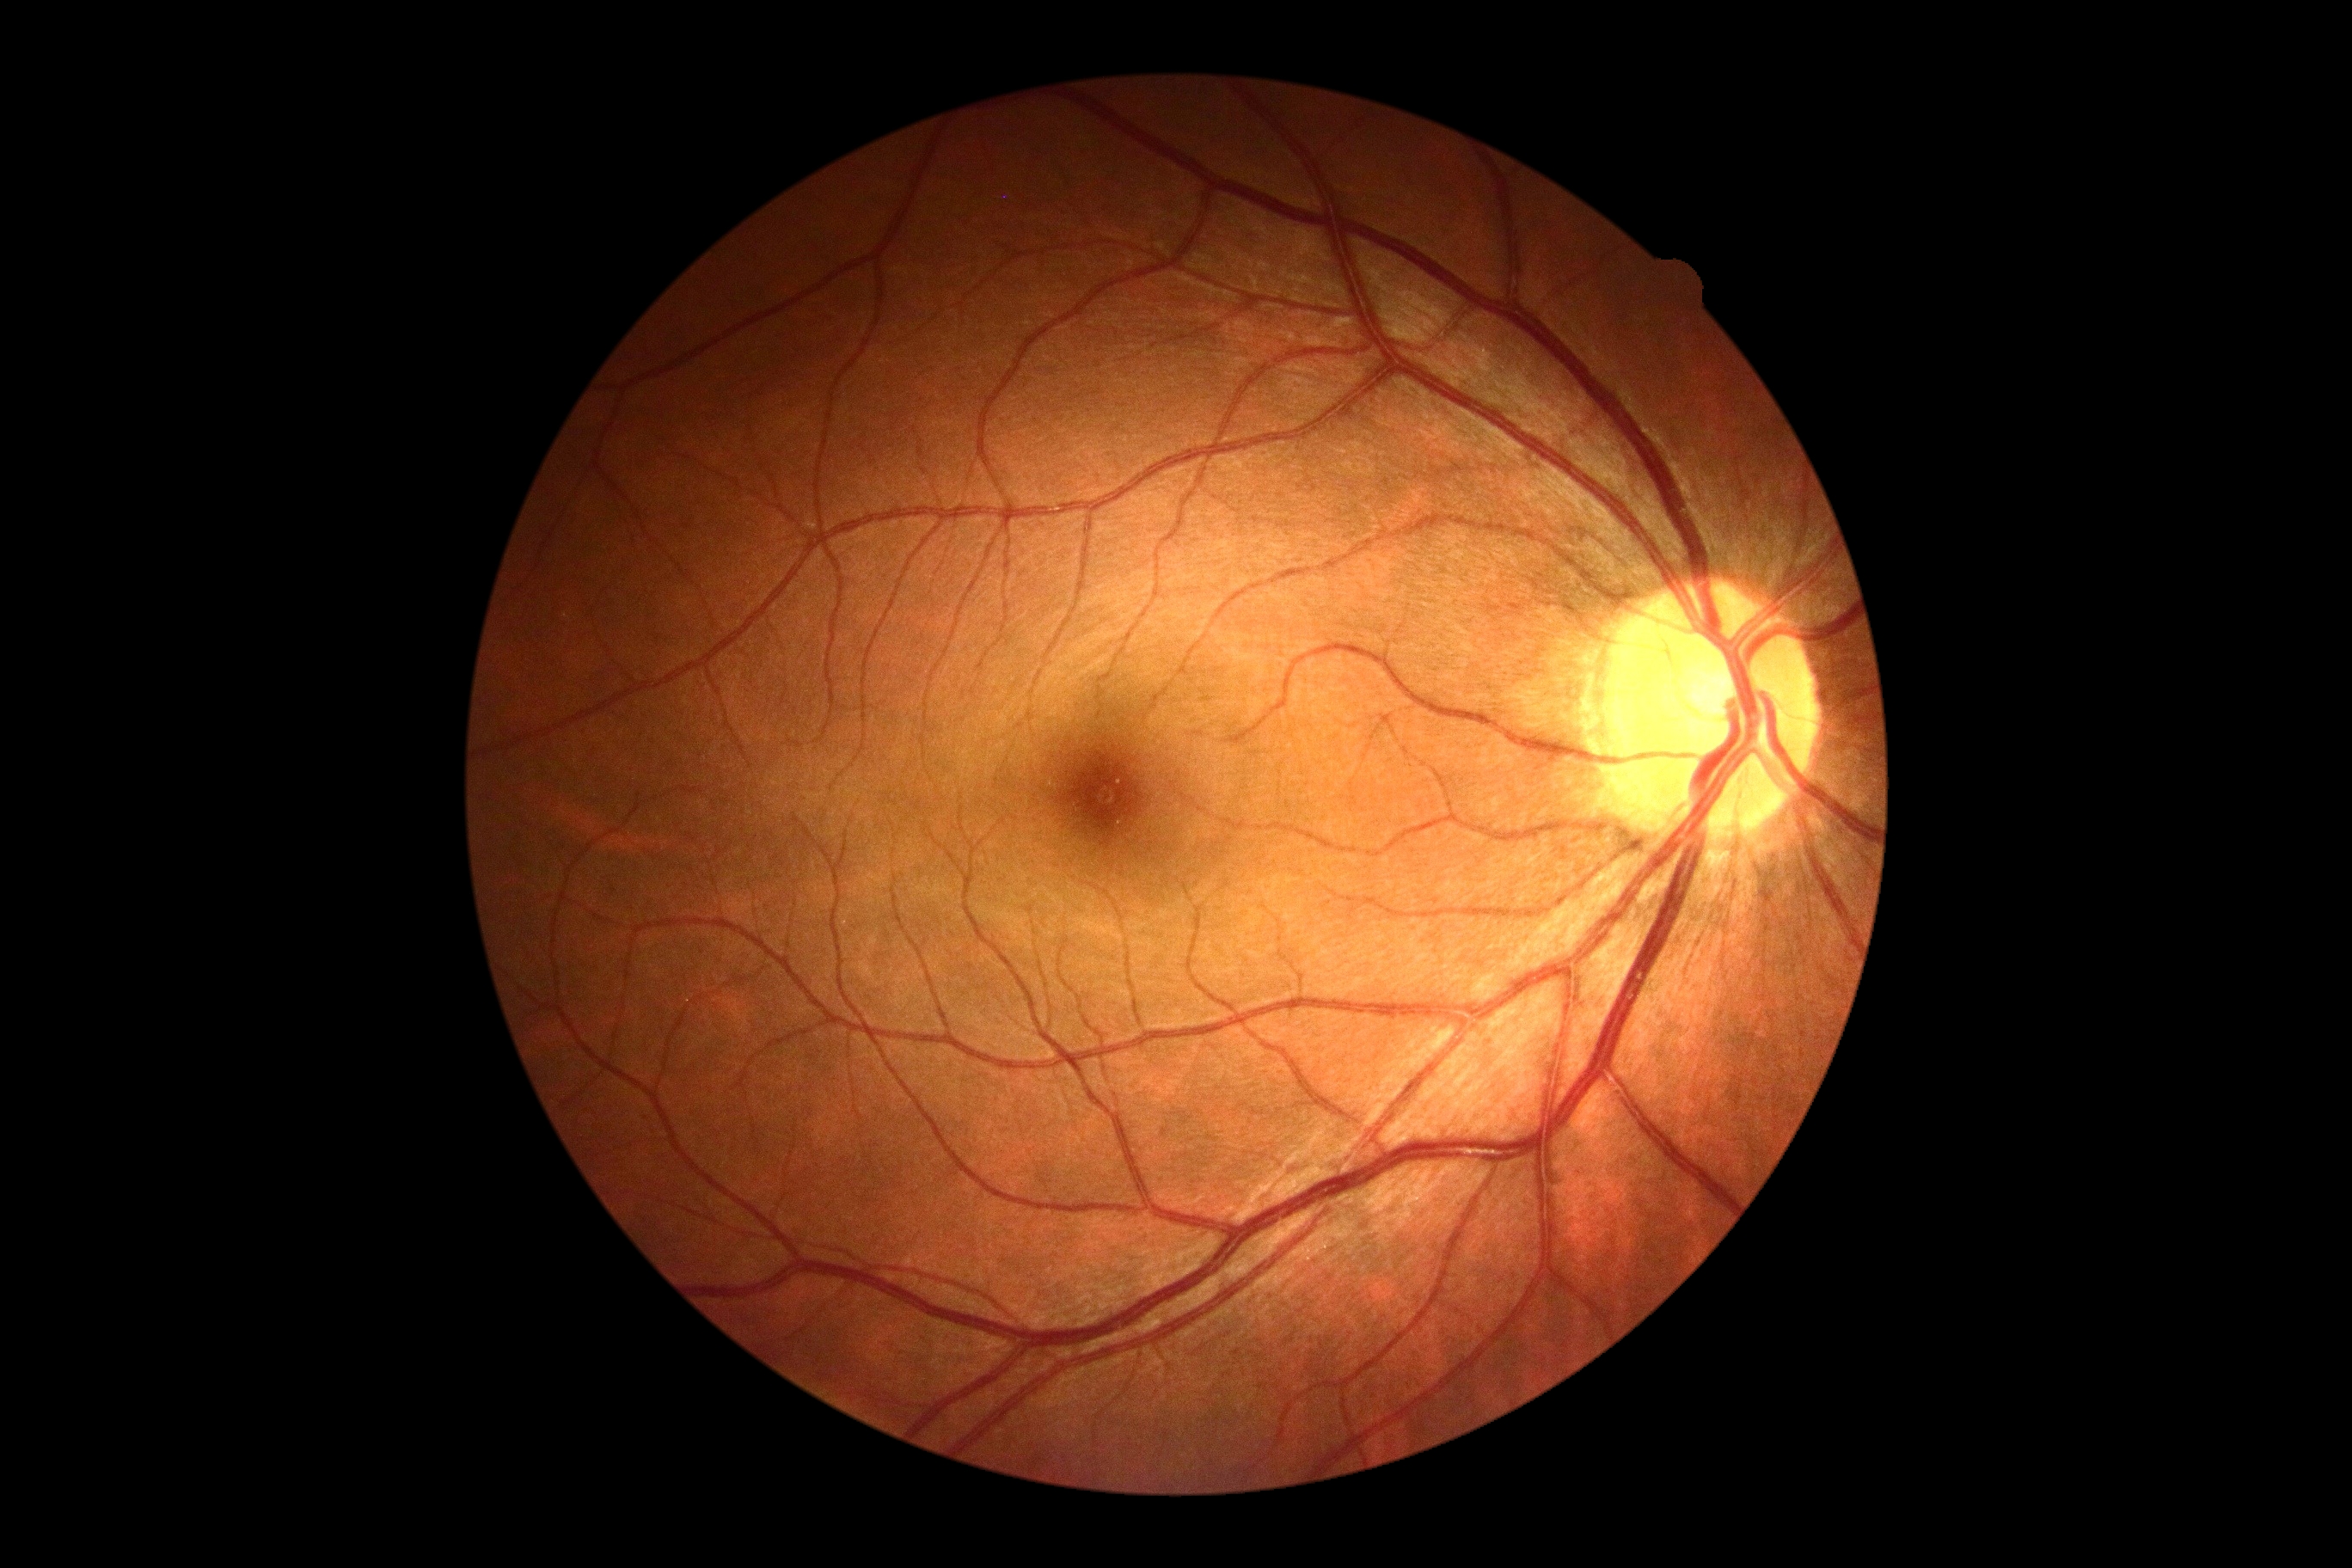 Diabetic retinopathy grade is 0 (no apparent retinopathy). No signs of diabetic retinopathy.